Wide-field fundus image from infant ROP screening · 100° field of view (Phoenix ICON) · 1240x1240px — 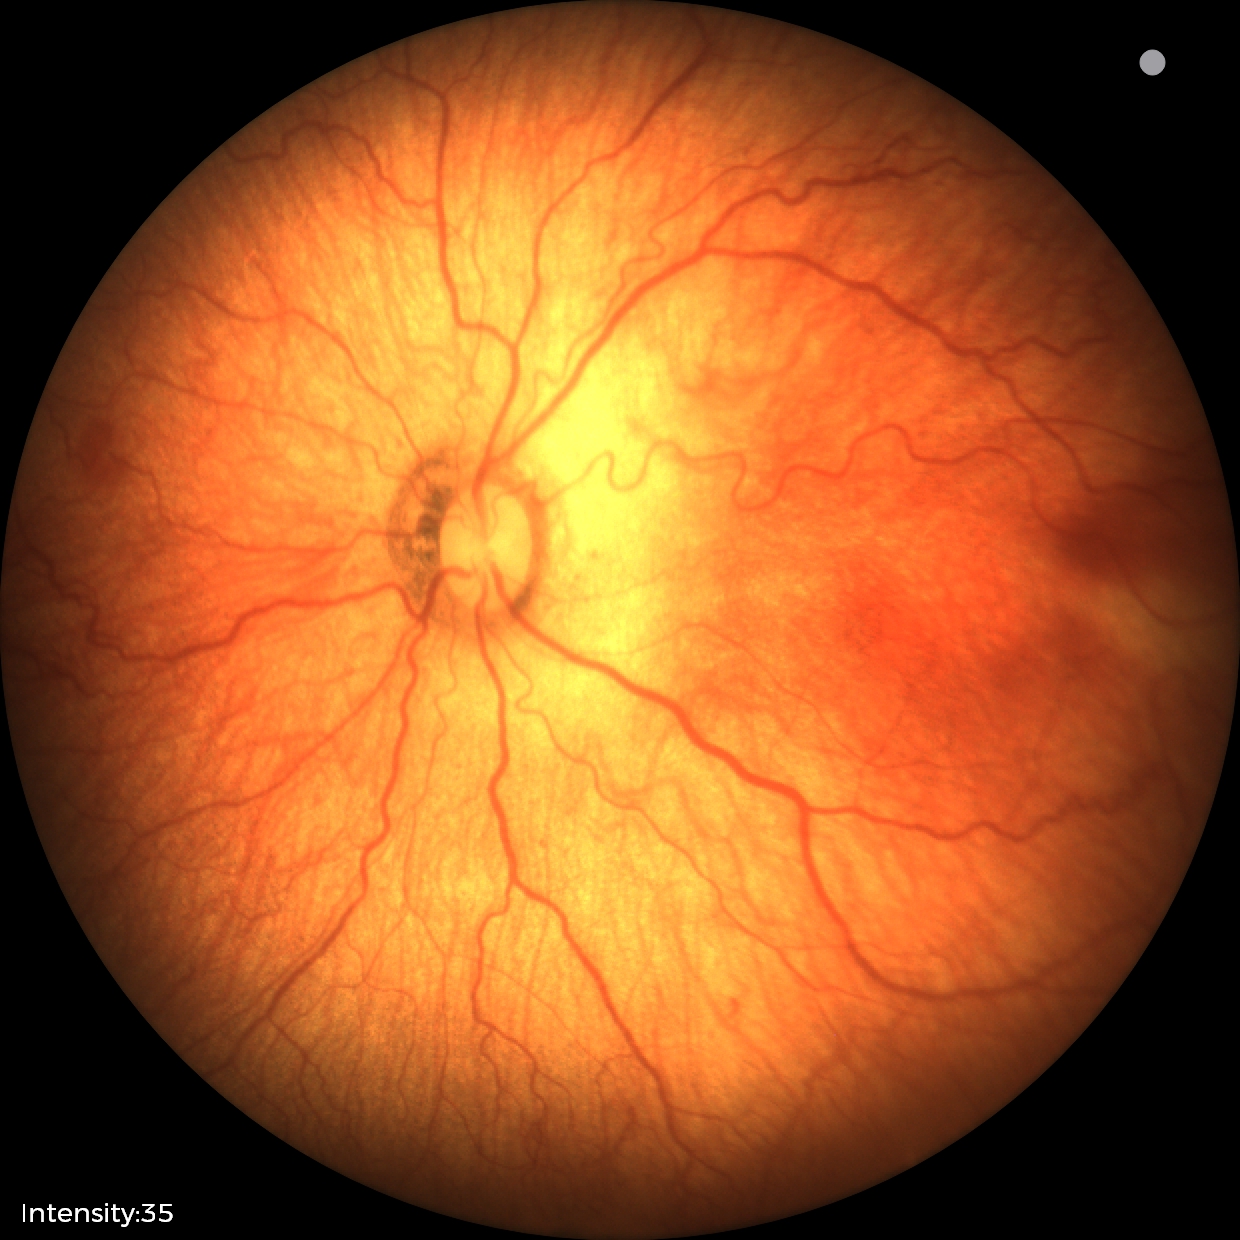
Q: What is the screening diagnosis?
A: retinopathy of prematurity (ROP) stage 1